45 degree fundus photograph, image size 848x848, diabetic retinopathy graded by the modified Davis classification, no pharmacologic dilation:
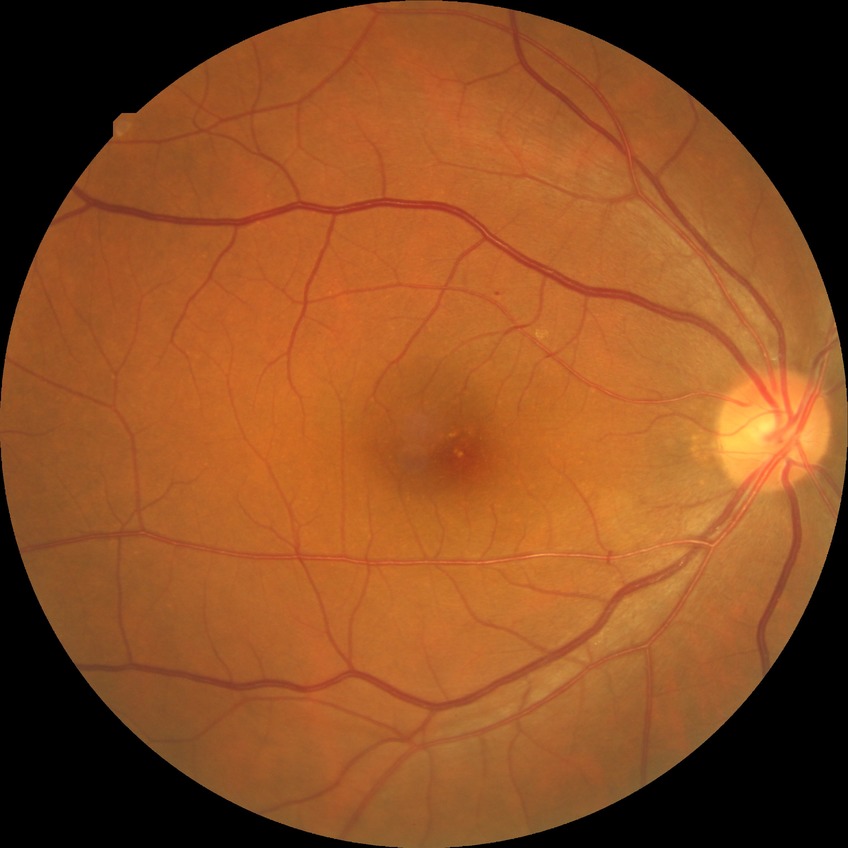

Assessment:
- Davis grade: SDR